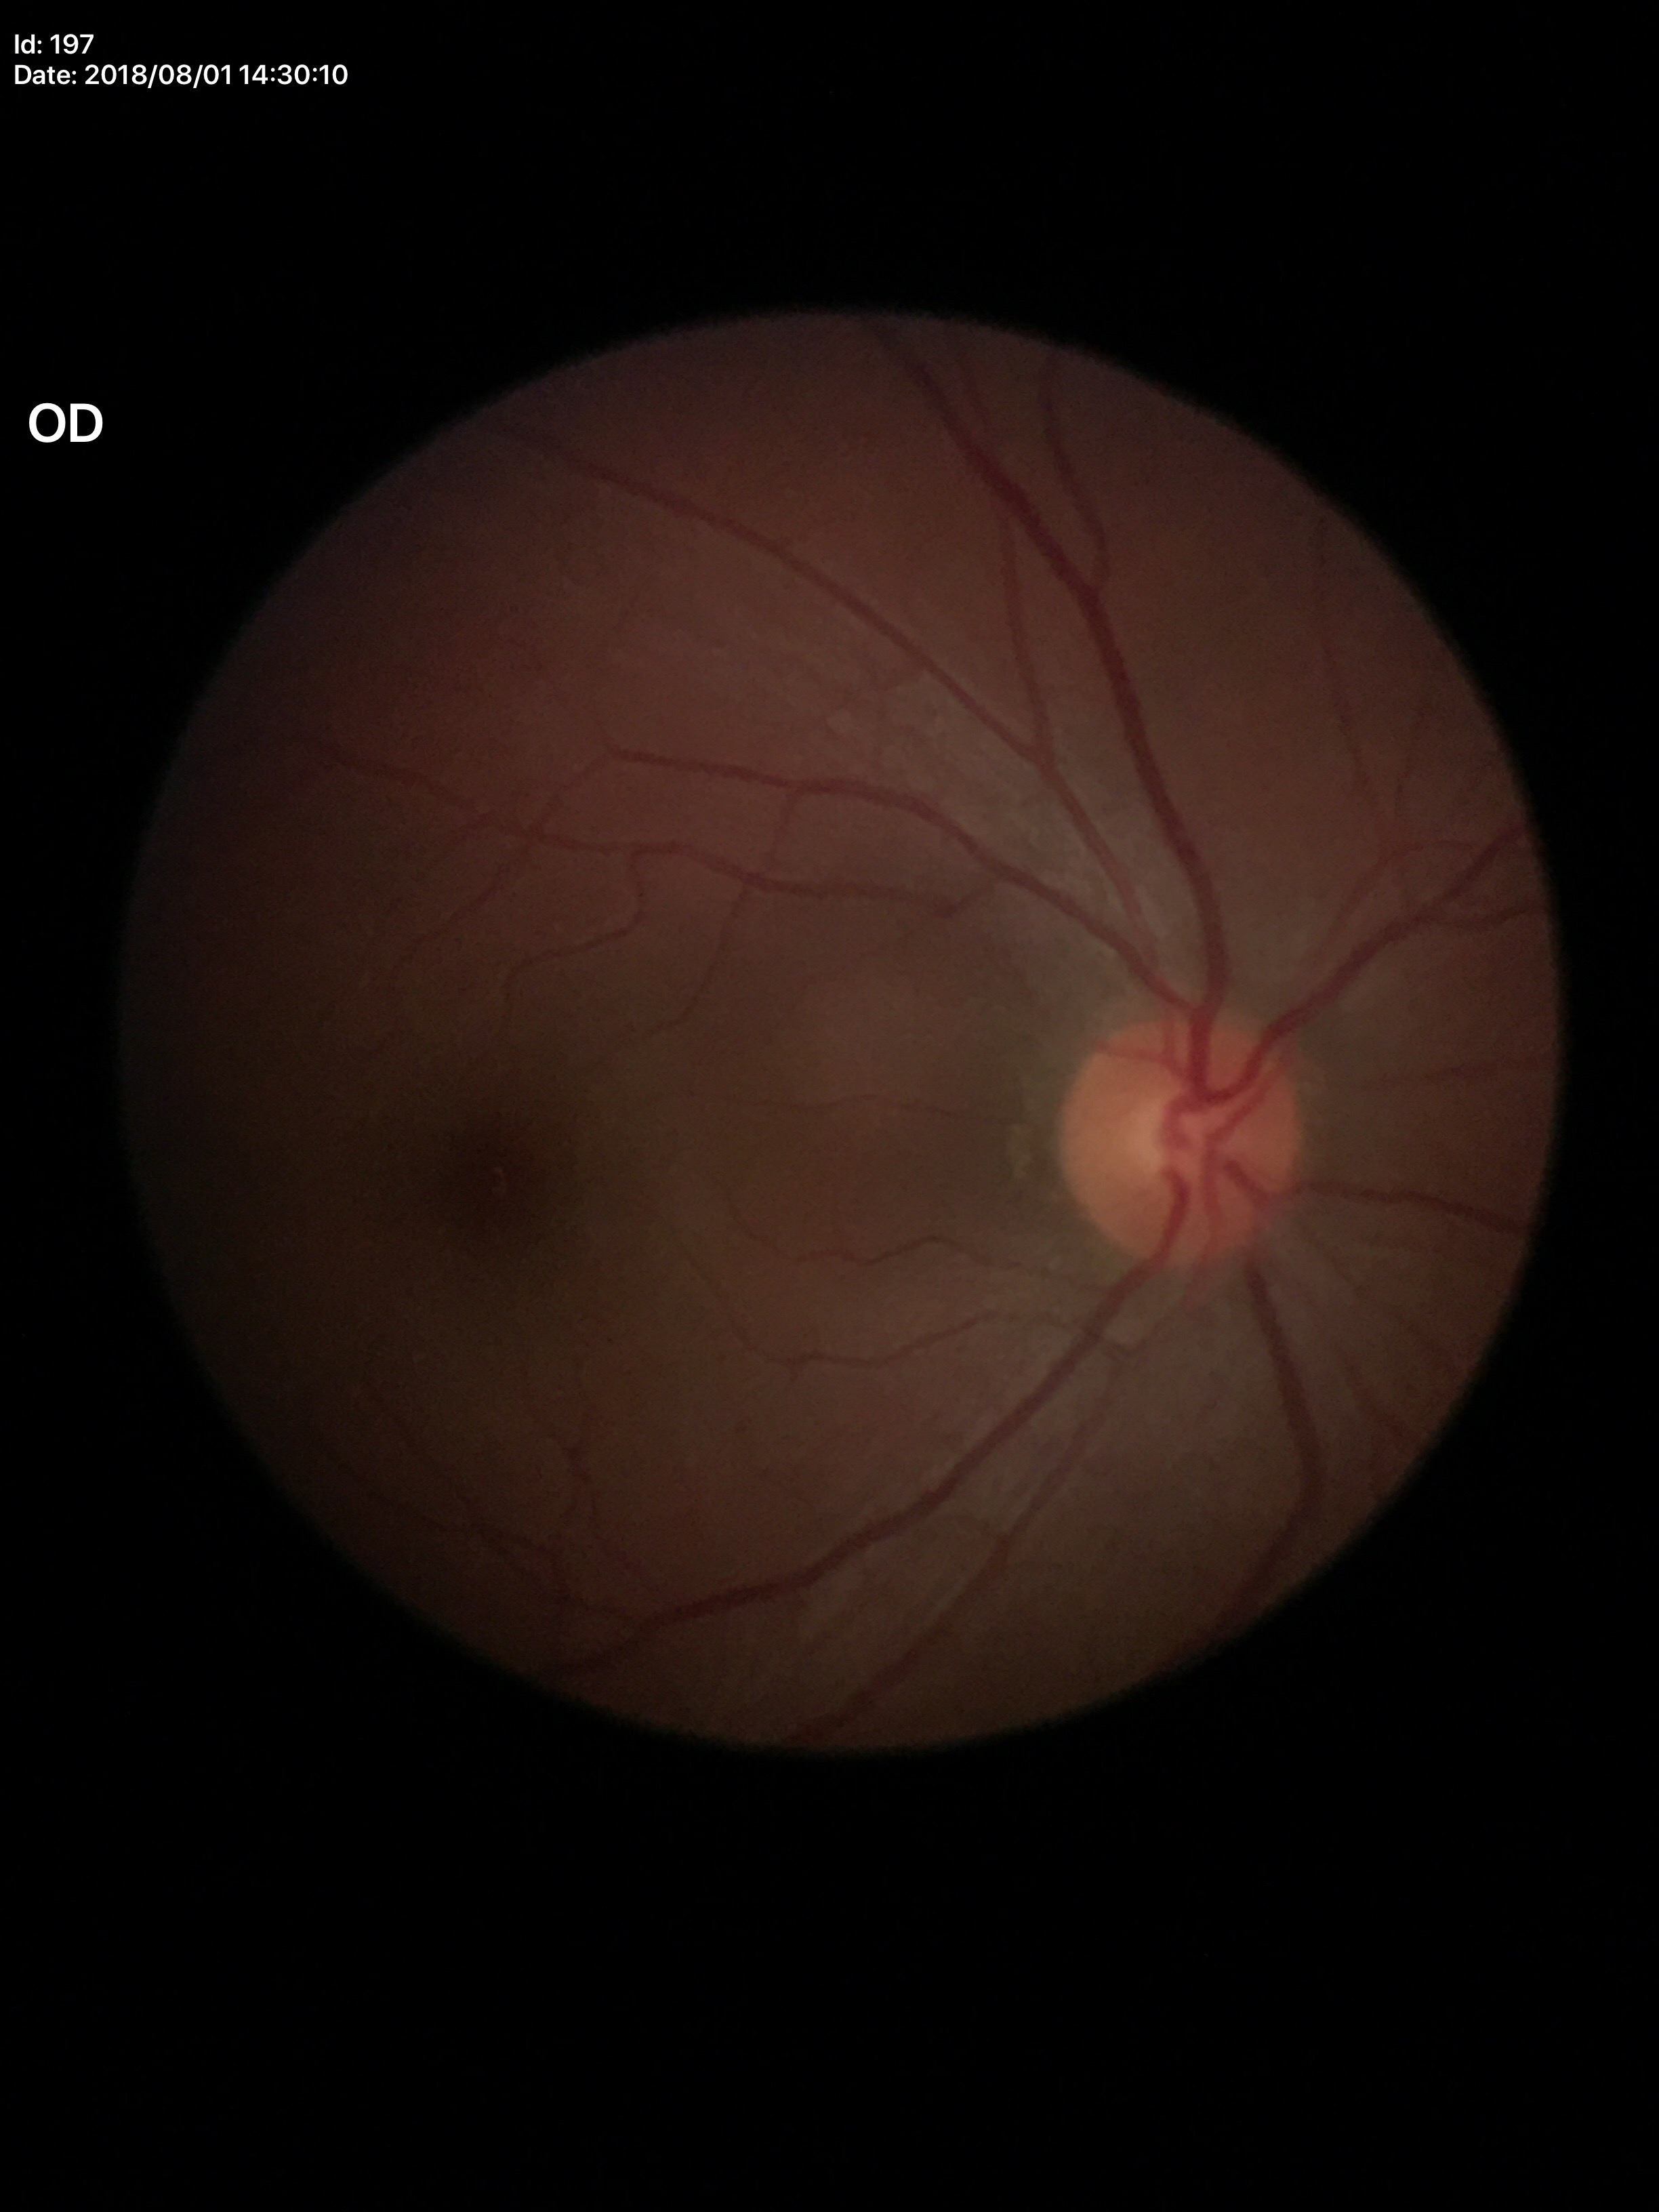 Q: Is there glaucoma suspicion?
A: no suspicious findings (5/5 ophthalmologists in agreement)
Q: What is the vertical cup-to-disc ratio?
A: 0.50
Q: Horizontal CDR?
A: 0.50